Pediatric wide-field fundus photograph: 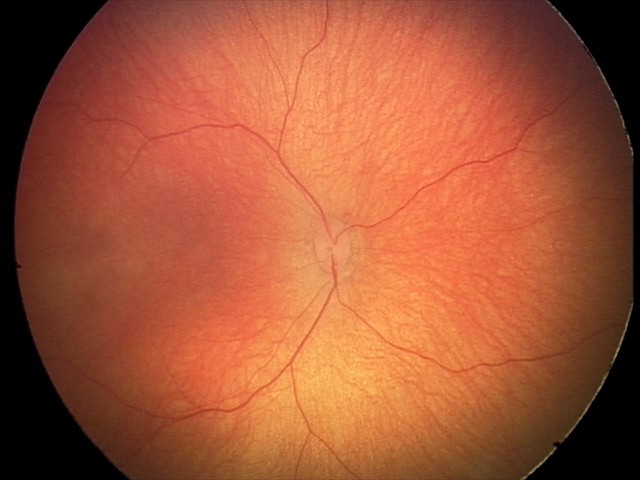

Screening examination consistent with retinal hemorrhages.